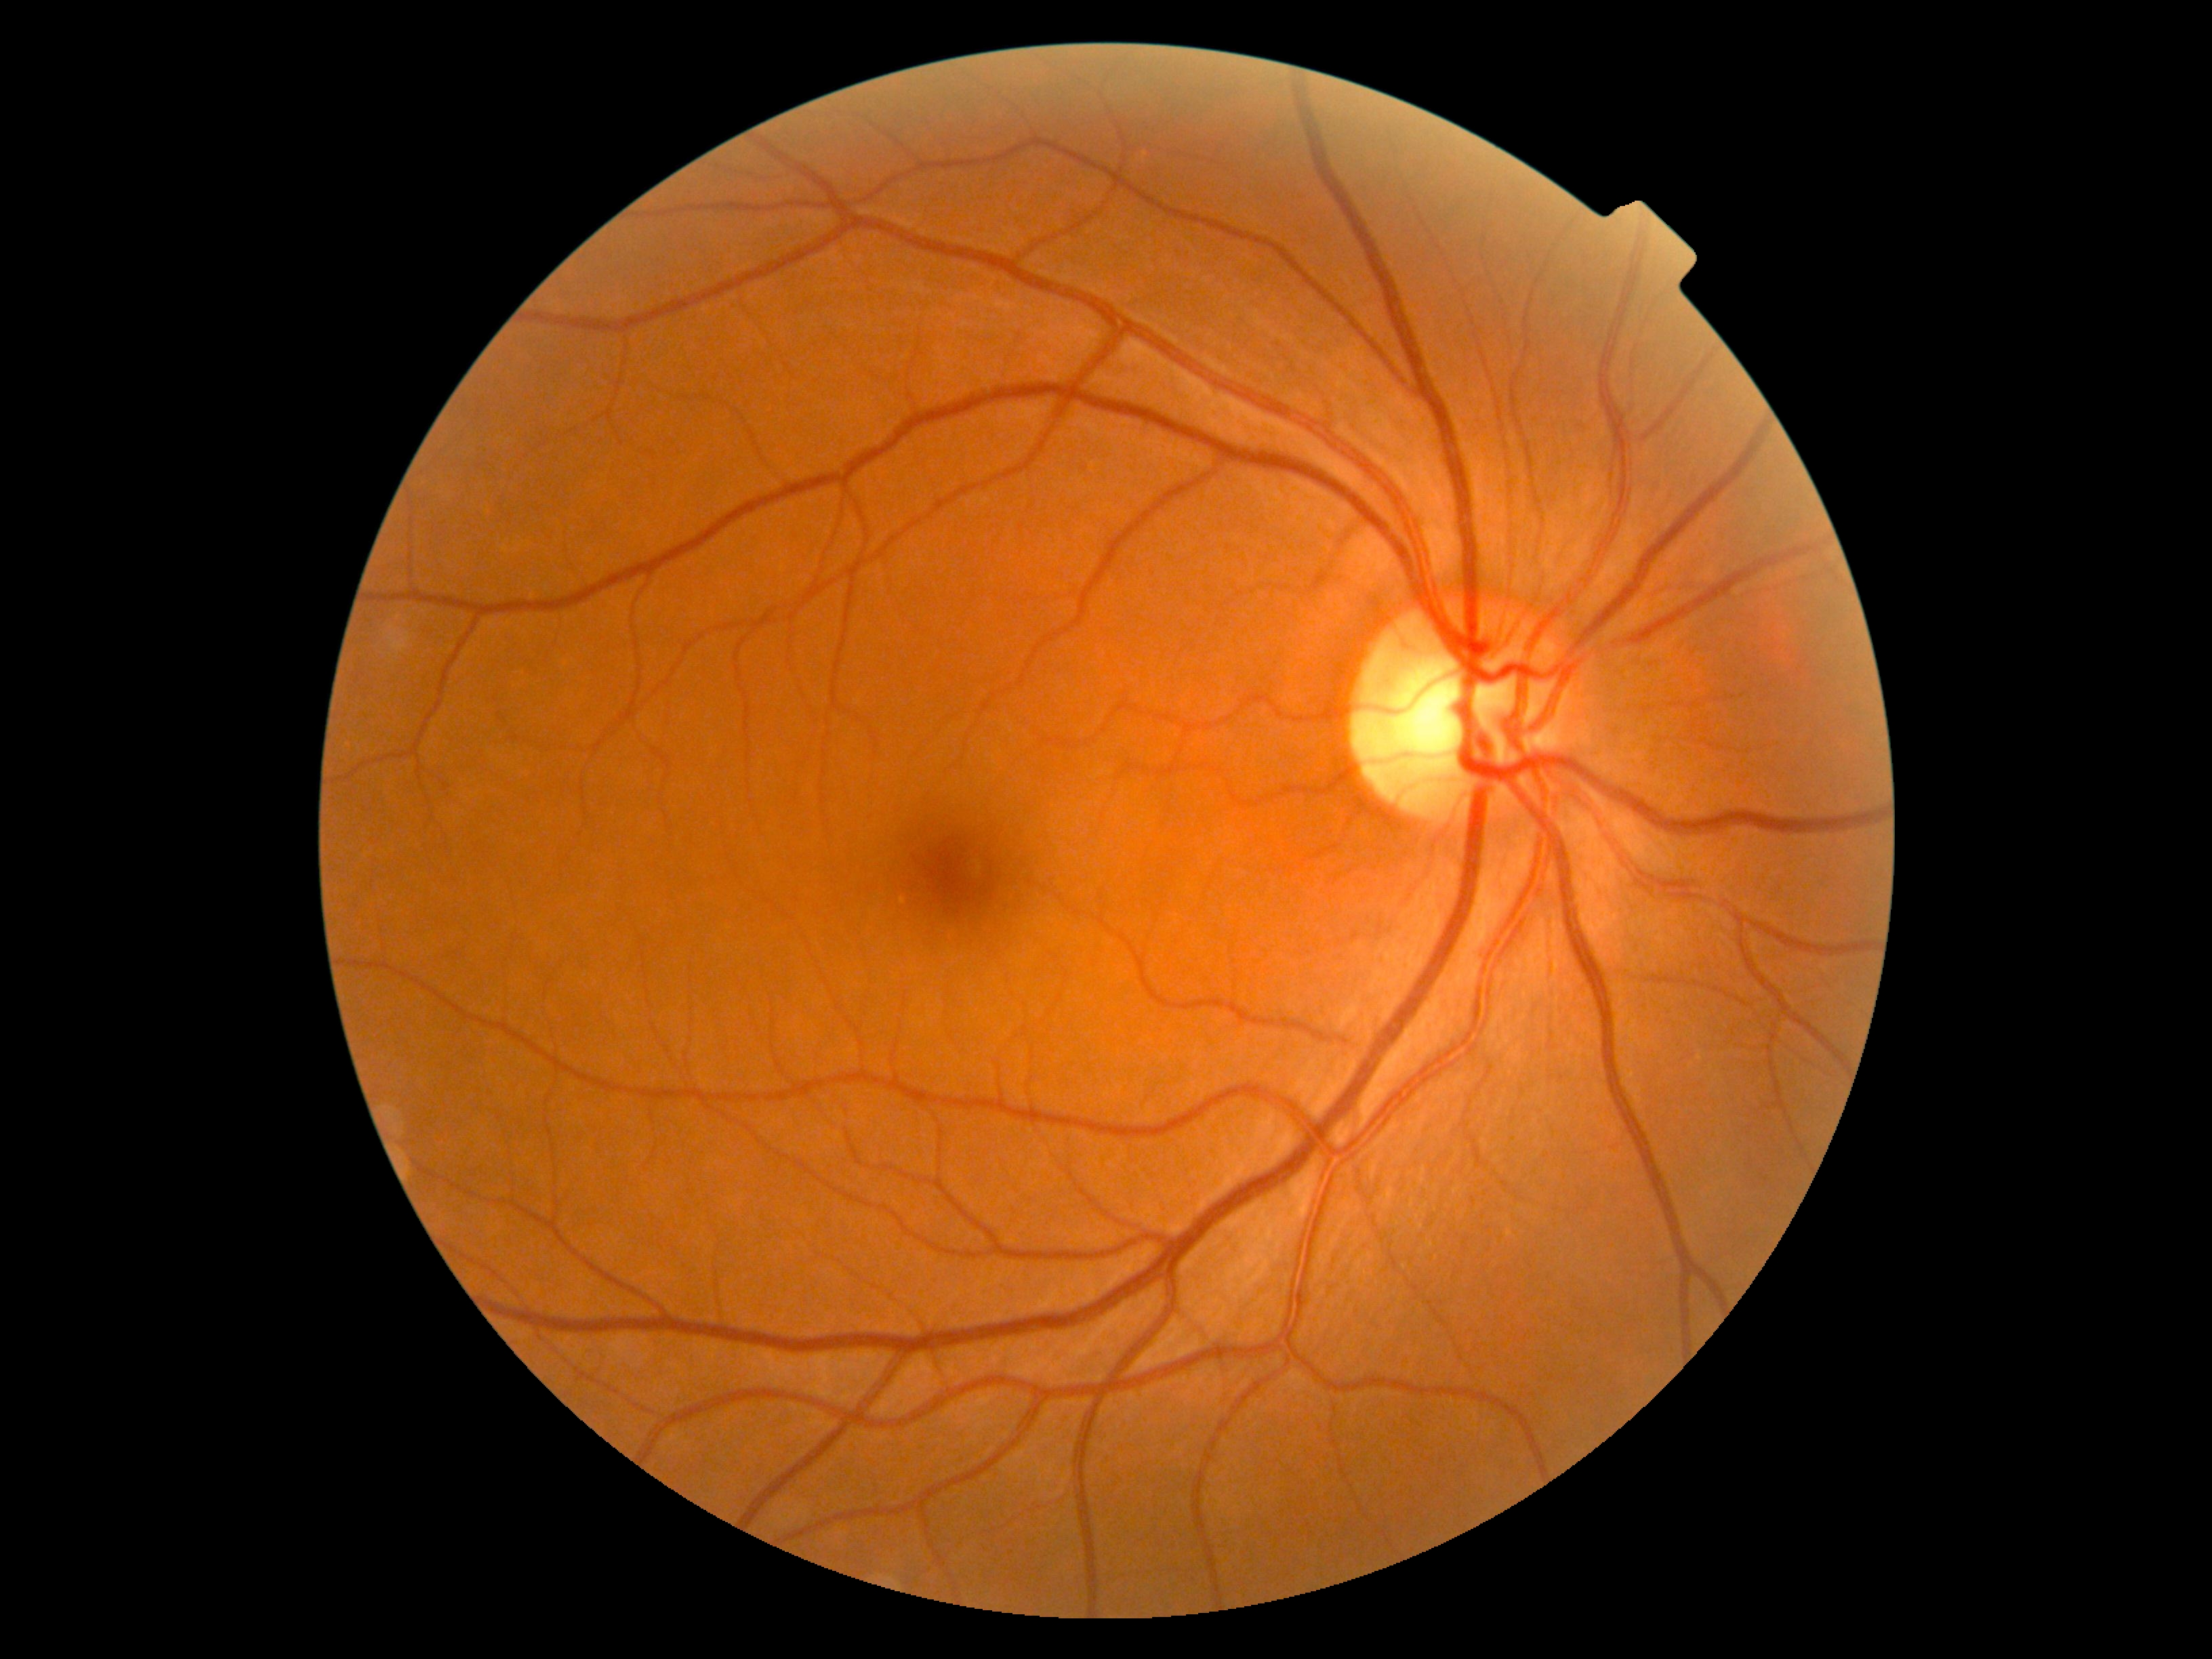
diabetic retinopathy (DR): 0/4 — no visible signs of diabetic retinopathy